Image size 2089x1764; retinal fundus photograph — 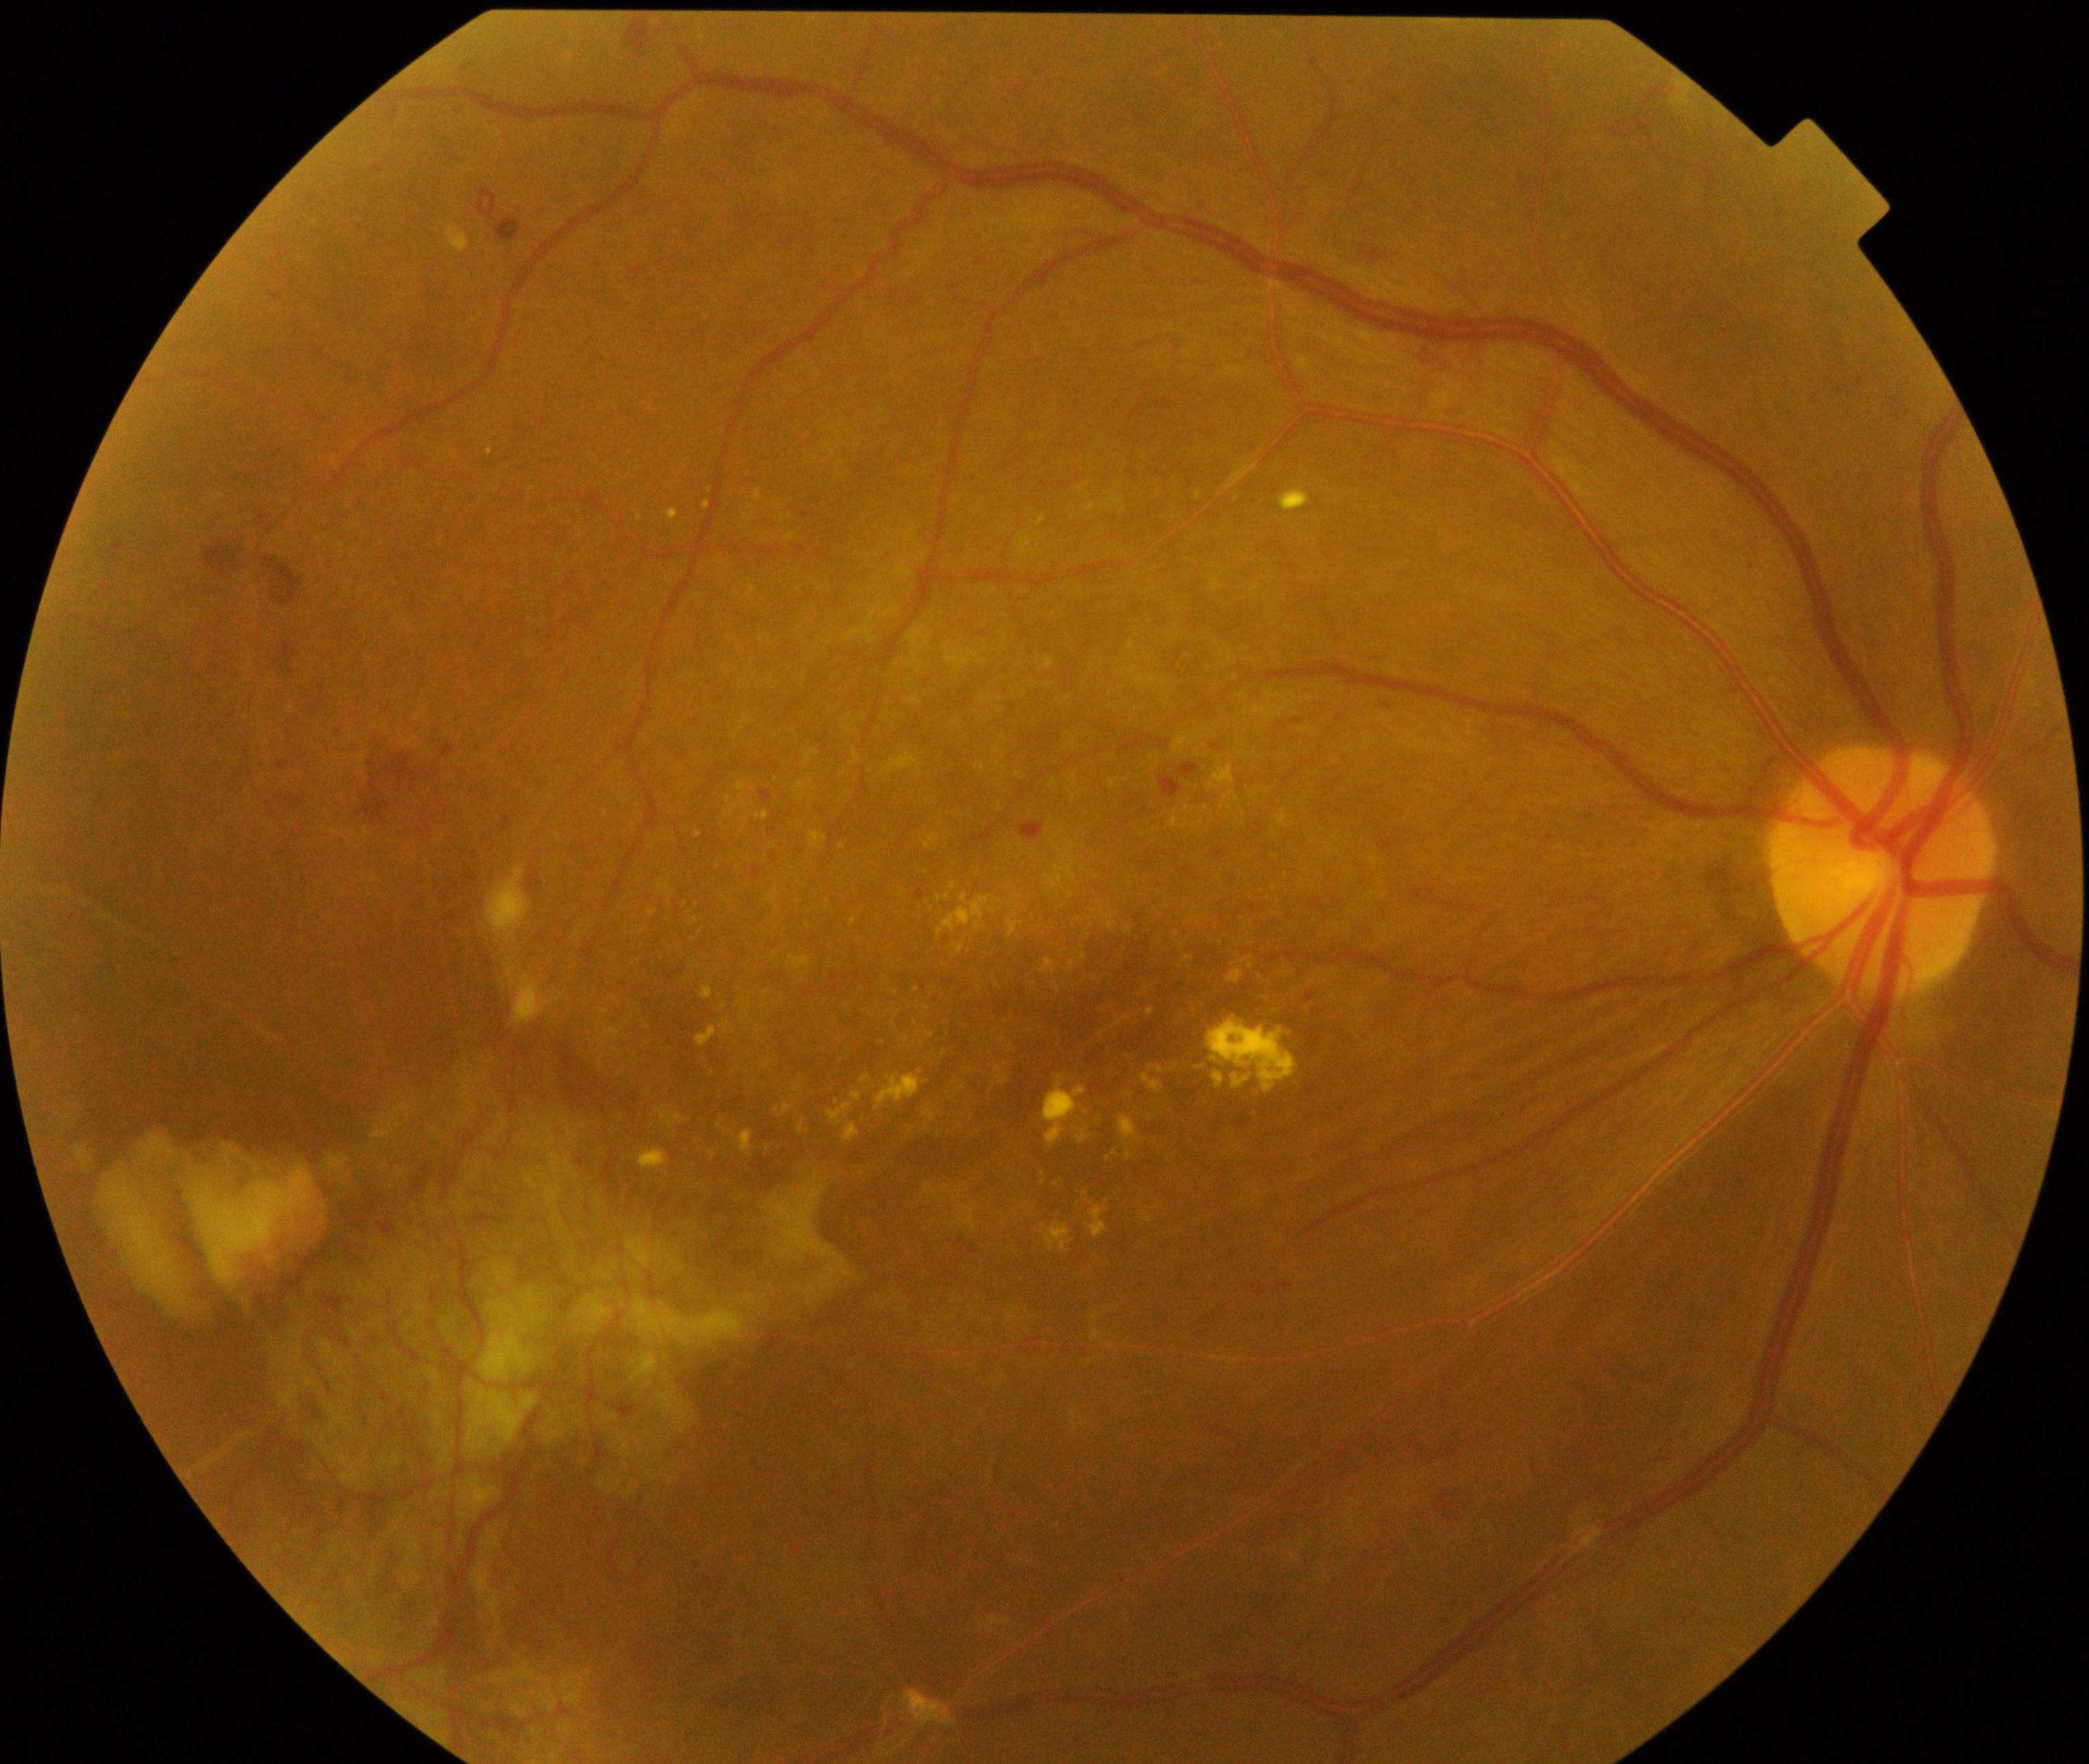

The image shows severe non-proliferative or proliferative diabetic retinopathy. Typically showing severe non-proliferative diabetic retinopathy or proliferative diabetic retinopathy with neovascularization or vitreous/preretinal hemorrhage.